640 x 480 pixels; infant wide-field retinal image
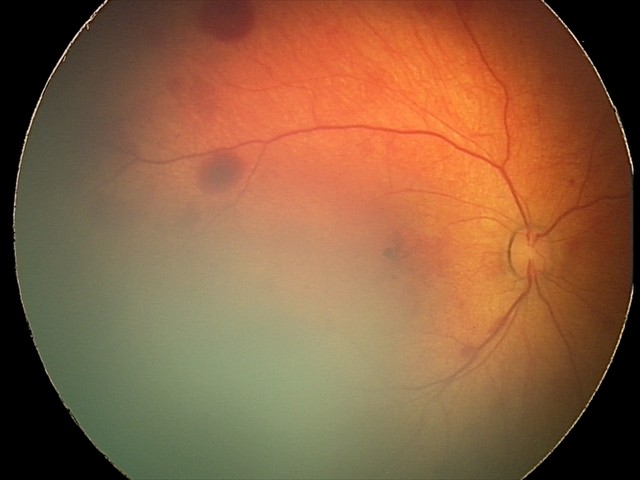 From an examination with diagnosis of retinal hemorrhages.